Infant wide-field retinal image. Captured with the Clarity RetCam 3 (130° field of view). 640 by 480 pixels:
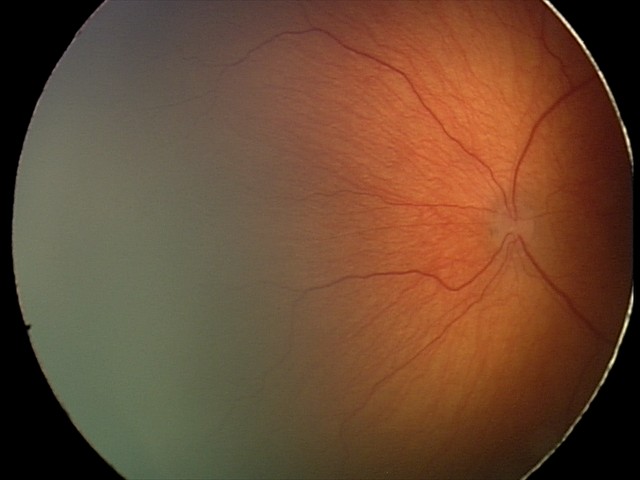 Q: What is the plus-form classification?
A: no plus disease
Q: What is the diagnosis from this examination?
A: ROP stage 2